Diabetic retinopathy graded by the modified Davis classification · nonmydriatic · NIDEK AFC-230:
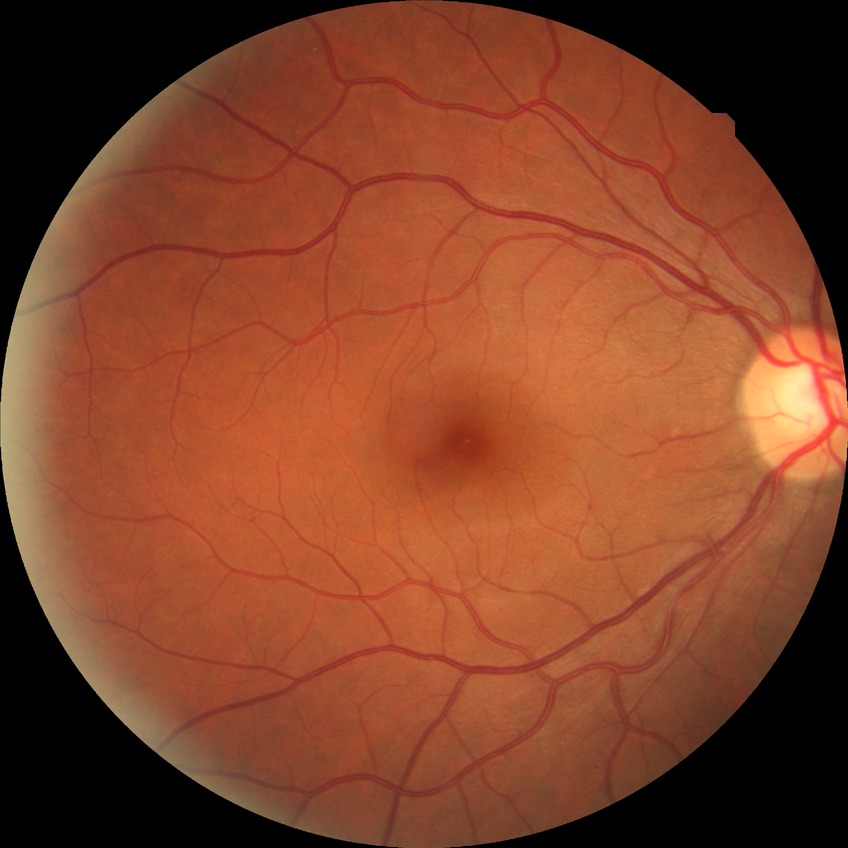
retinopathy stage: no diabetic retinopathy.